Acquired with a NIDEK AFC-230; without pupil dilation:
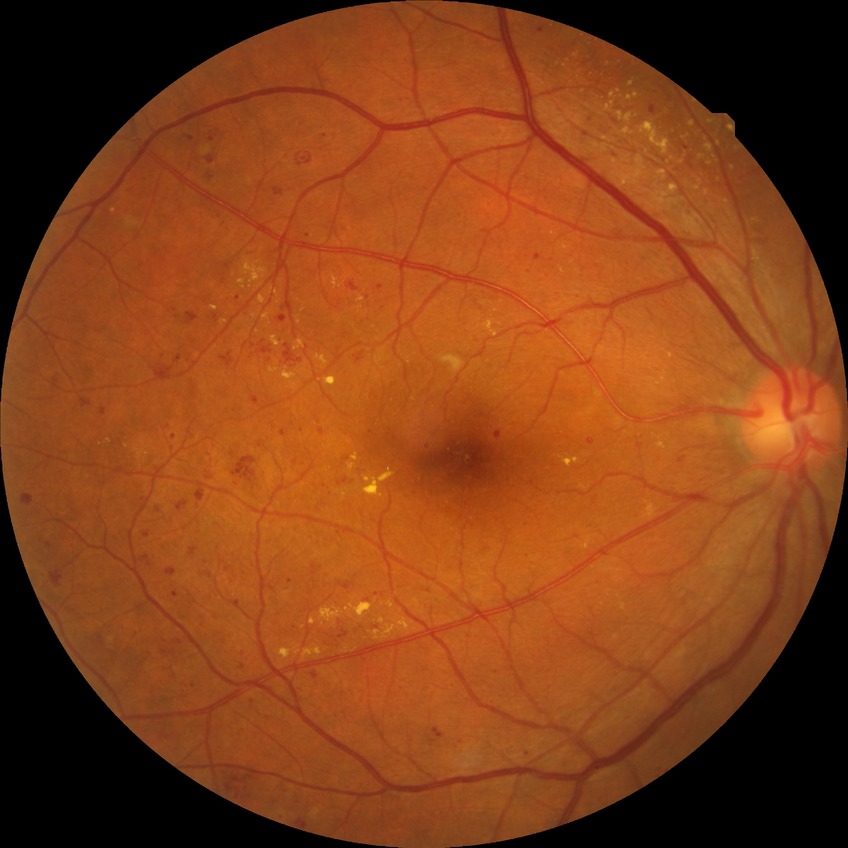
Diabetic retinopathy grade is pre-proliferative diabetic retinopathy.